2184x1690px: 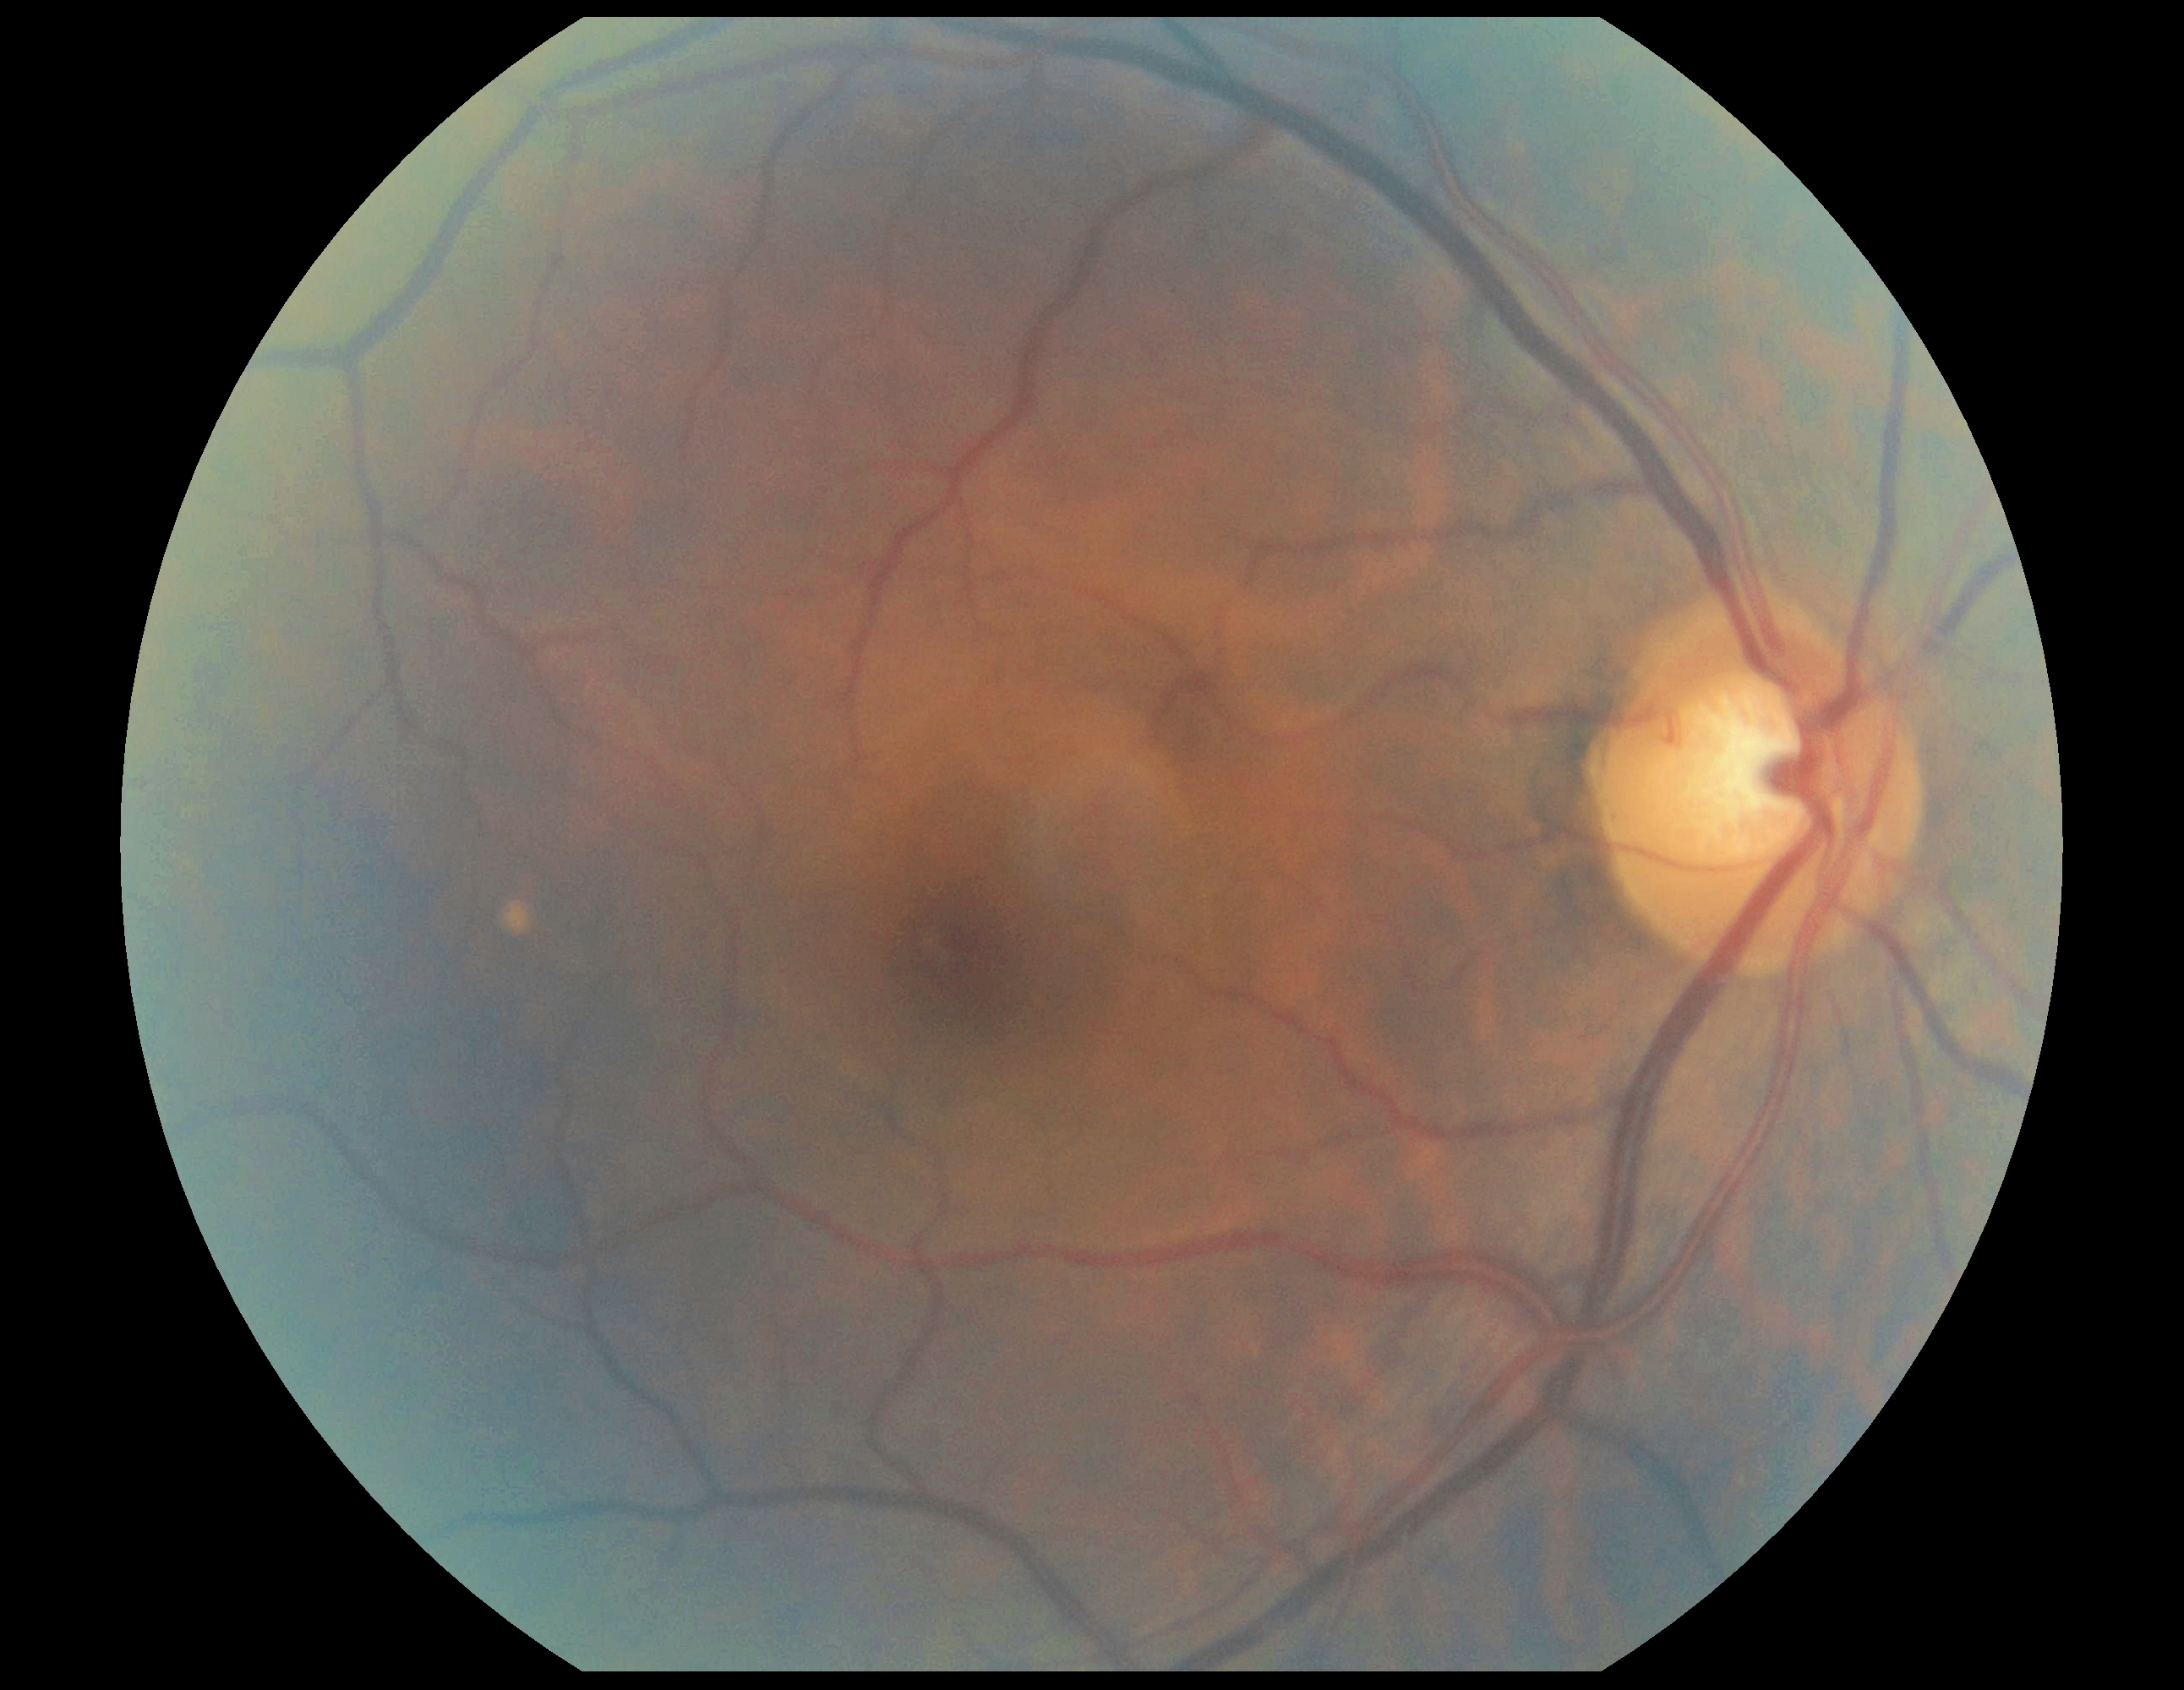 Diabetic retinopathy (DR): no apparent retinopathy (grade 0).